Fundus photo. Image size 2352x1568. 45° field of view: 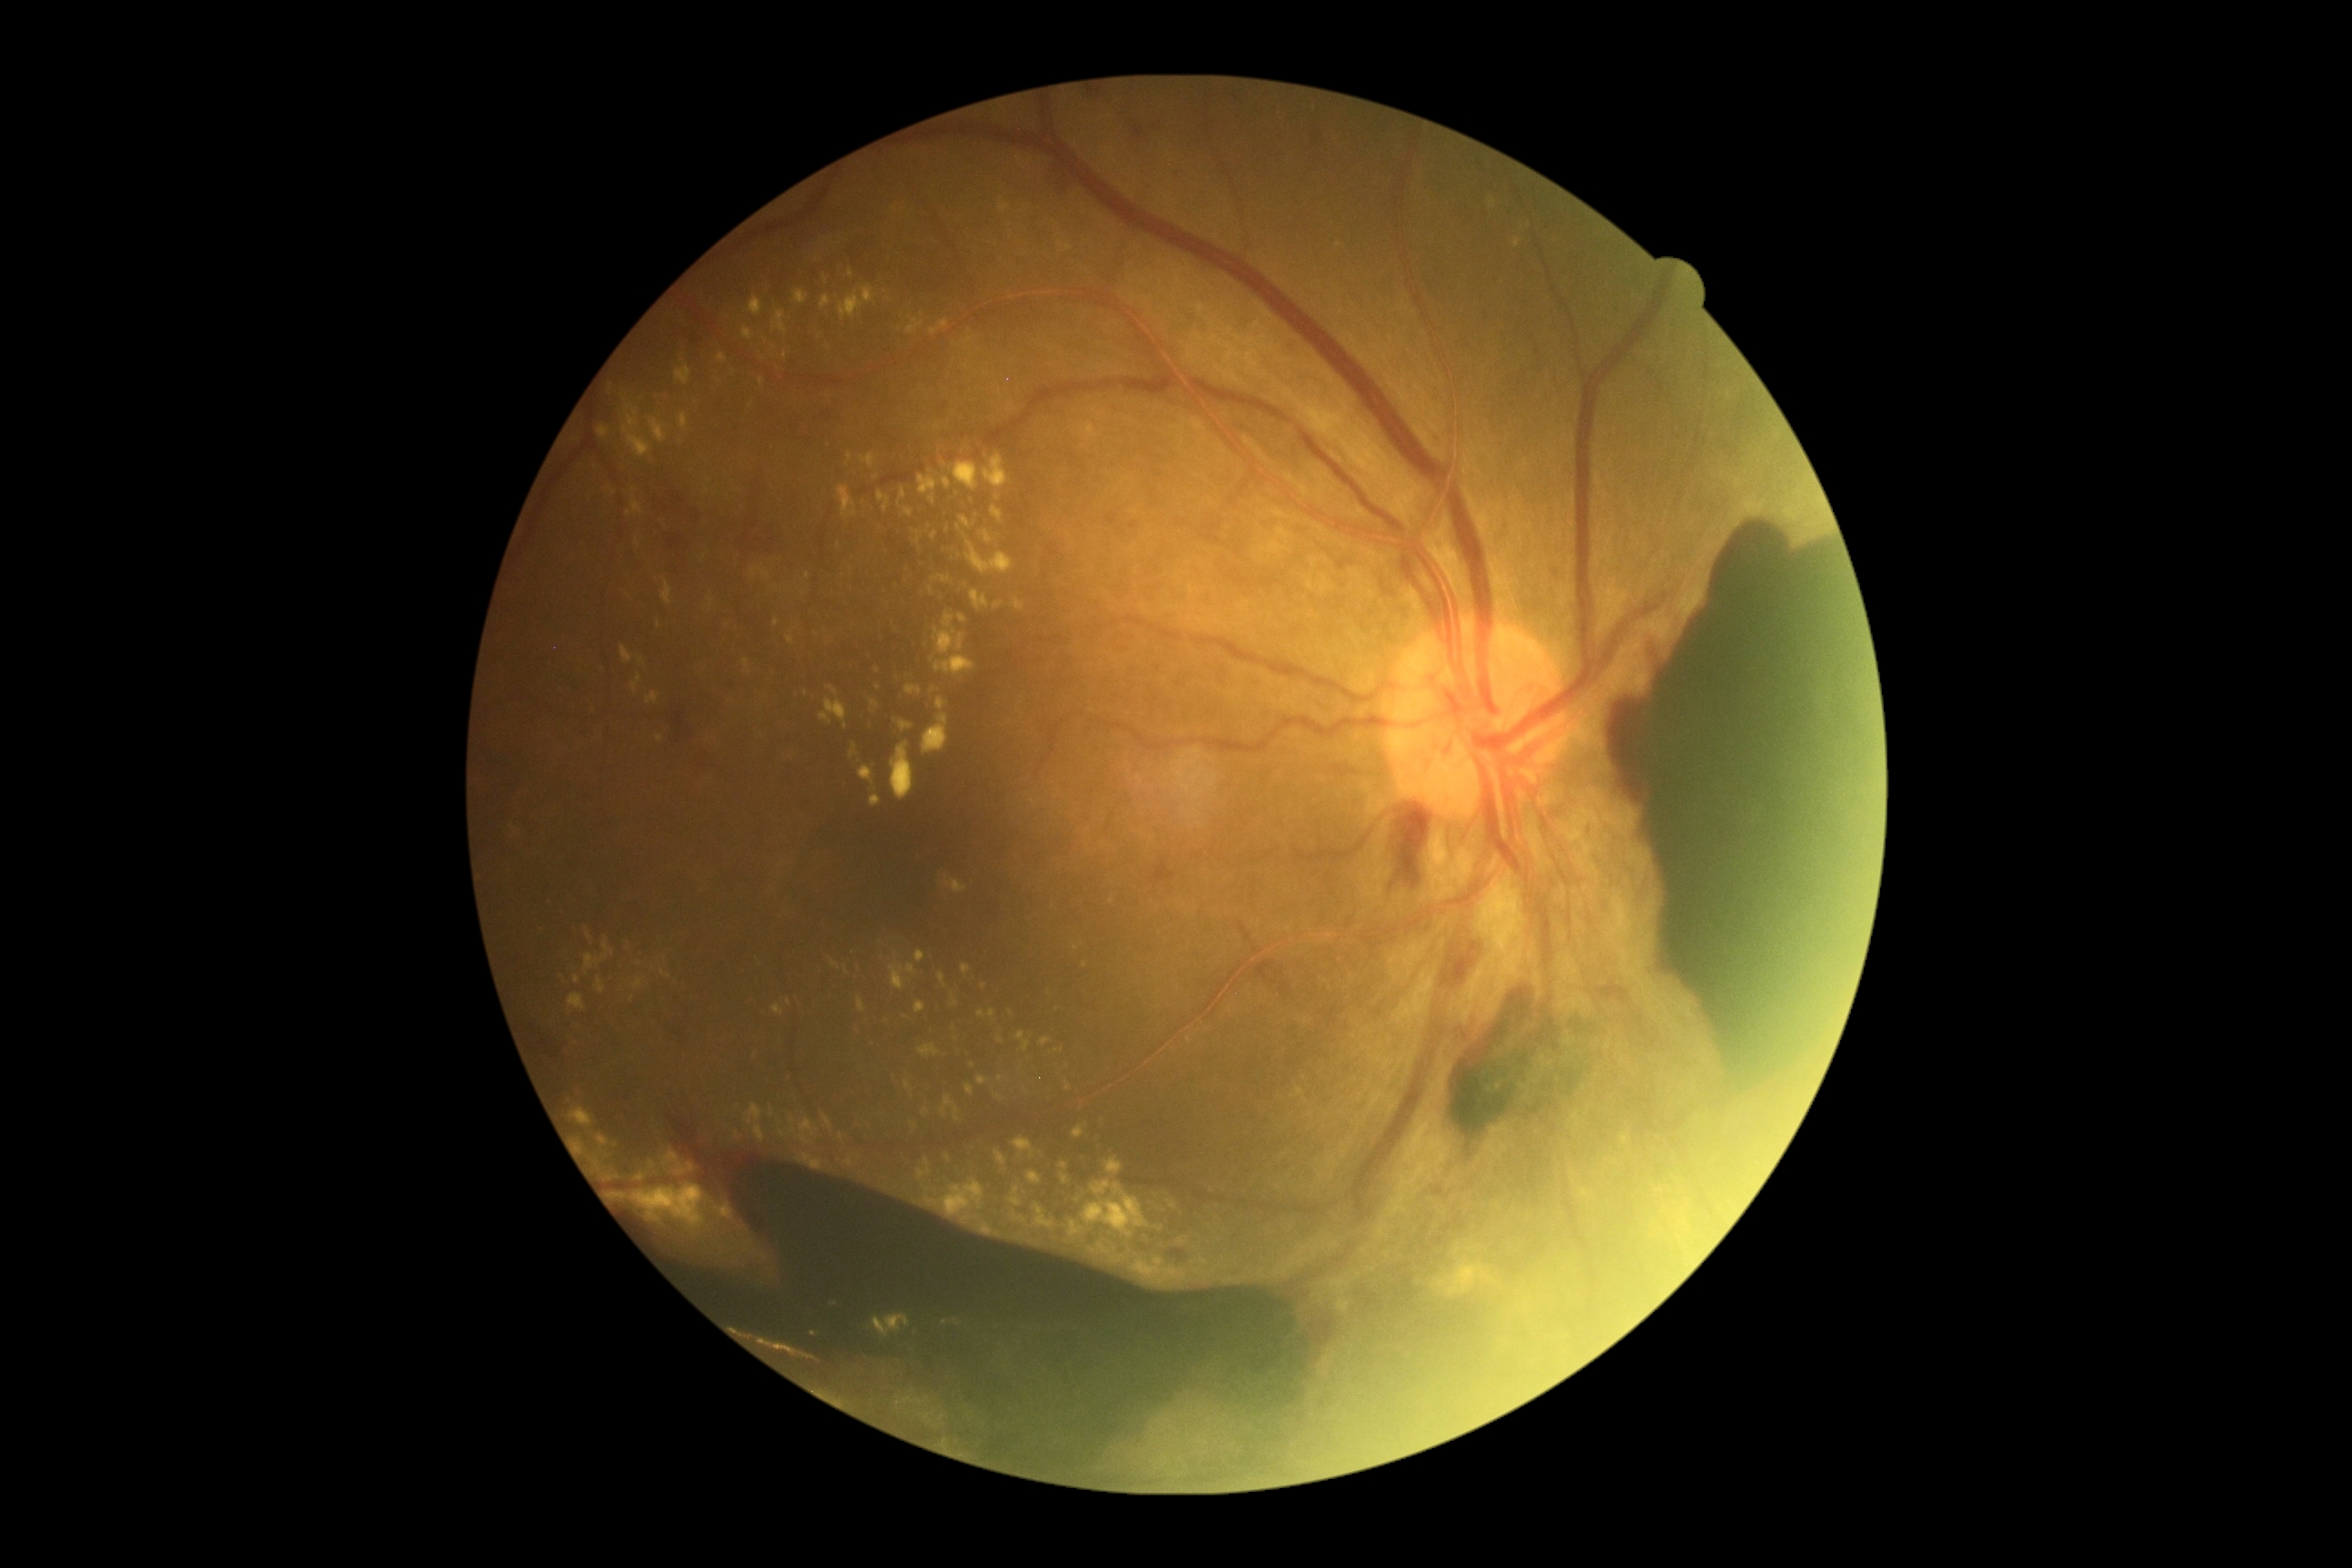
DR grade: 4.